Camera: Remidio FOP fundus camera · 1659x2212px.
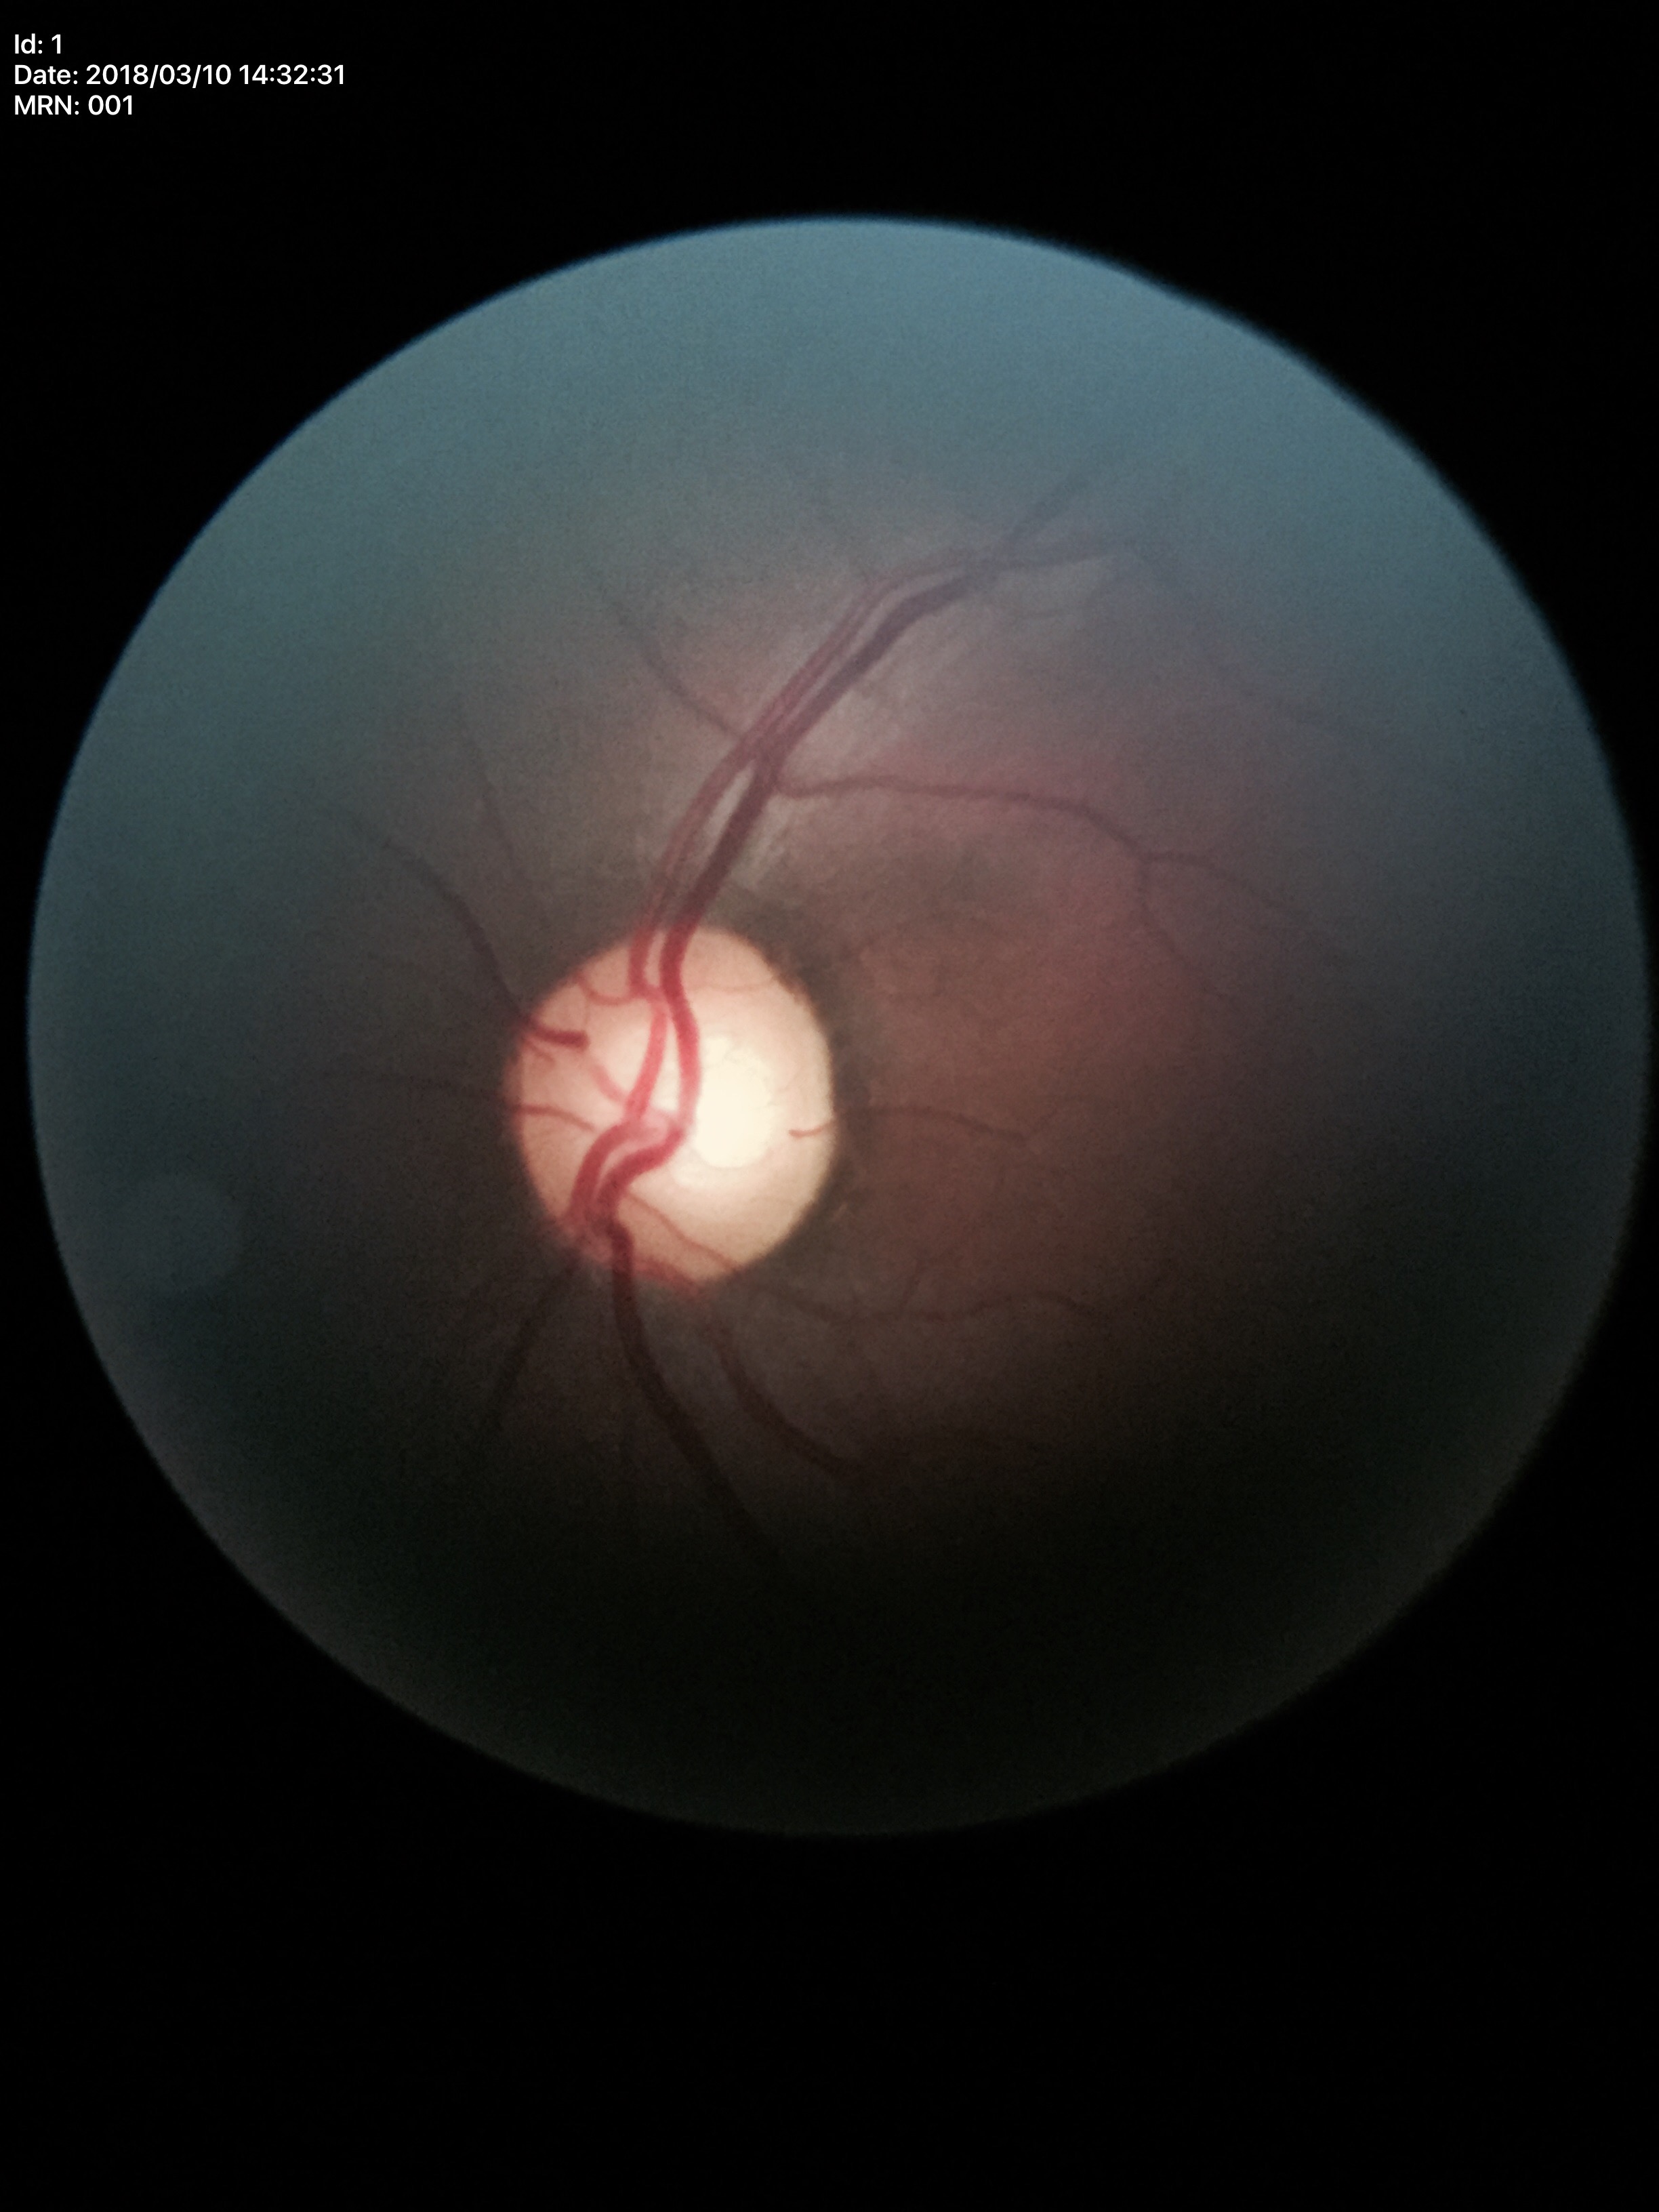
{
  "glaucoma_decision": "suspect",
  "vcdr": "0.64",
  "hcdr": "0.66"
}